1240 by 1240 pixels · infant wide-field retinal image: 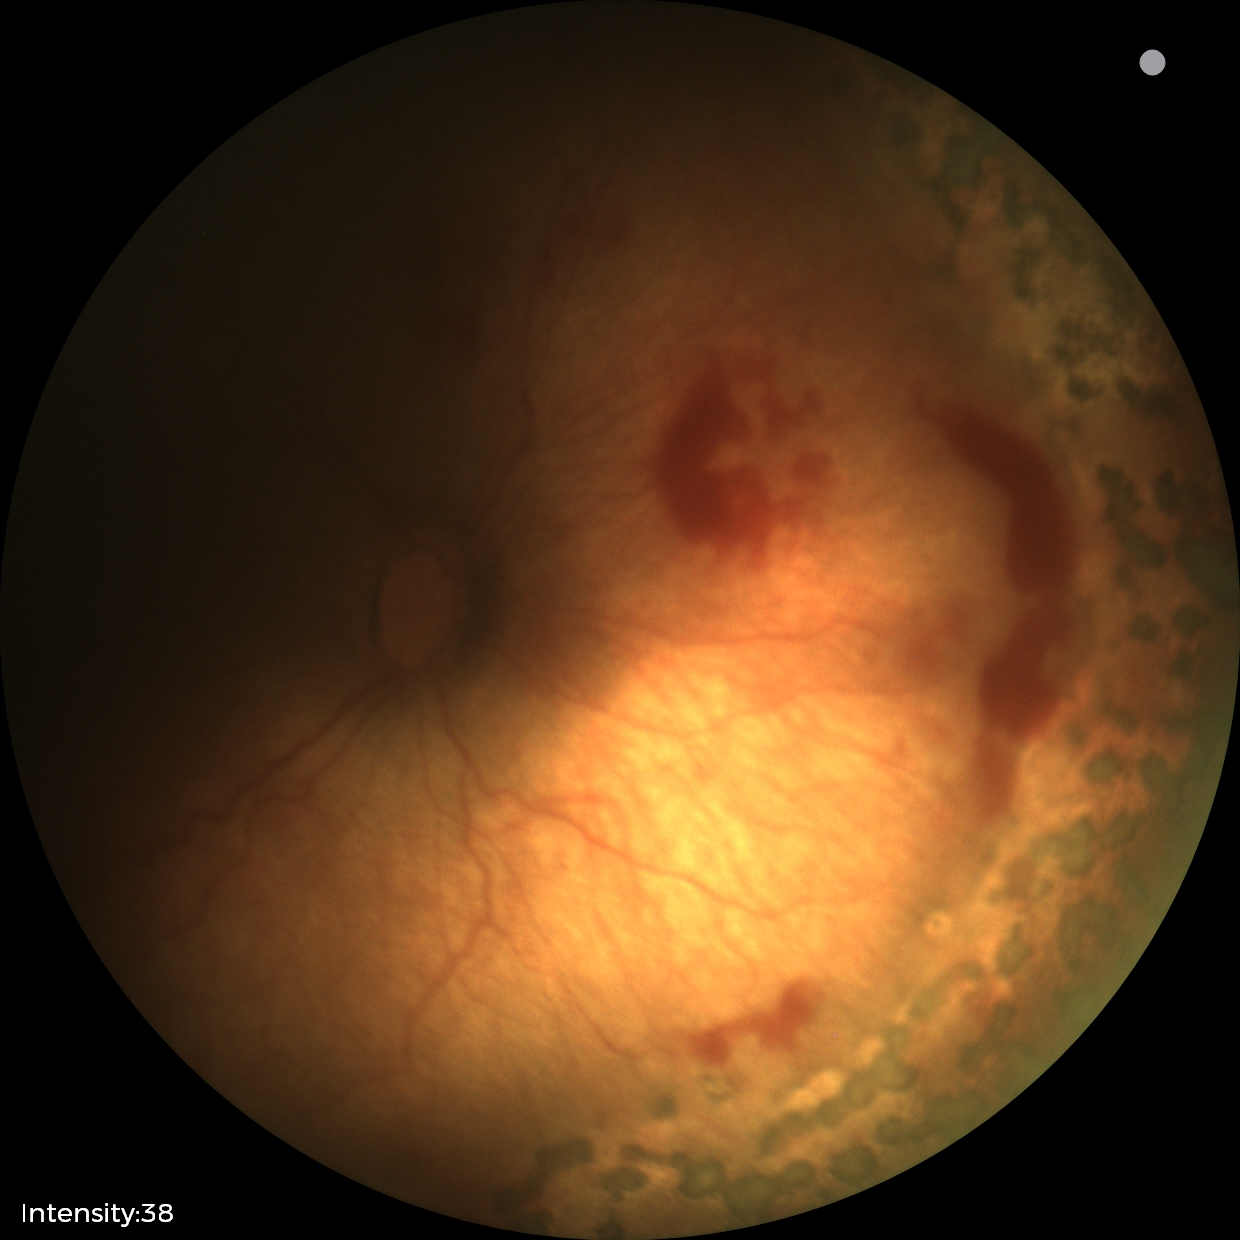
Diagnosis from this screening exam: status post retinopathy of prematurity.